Fundus photo:
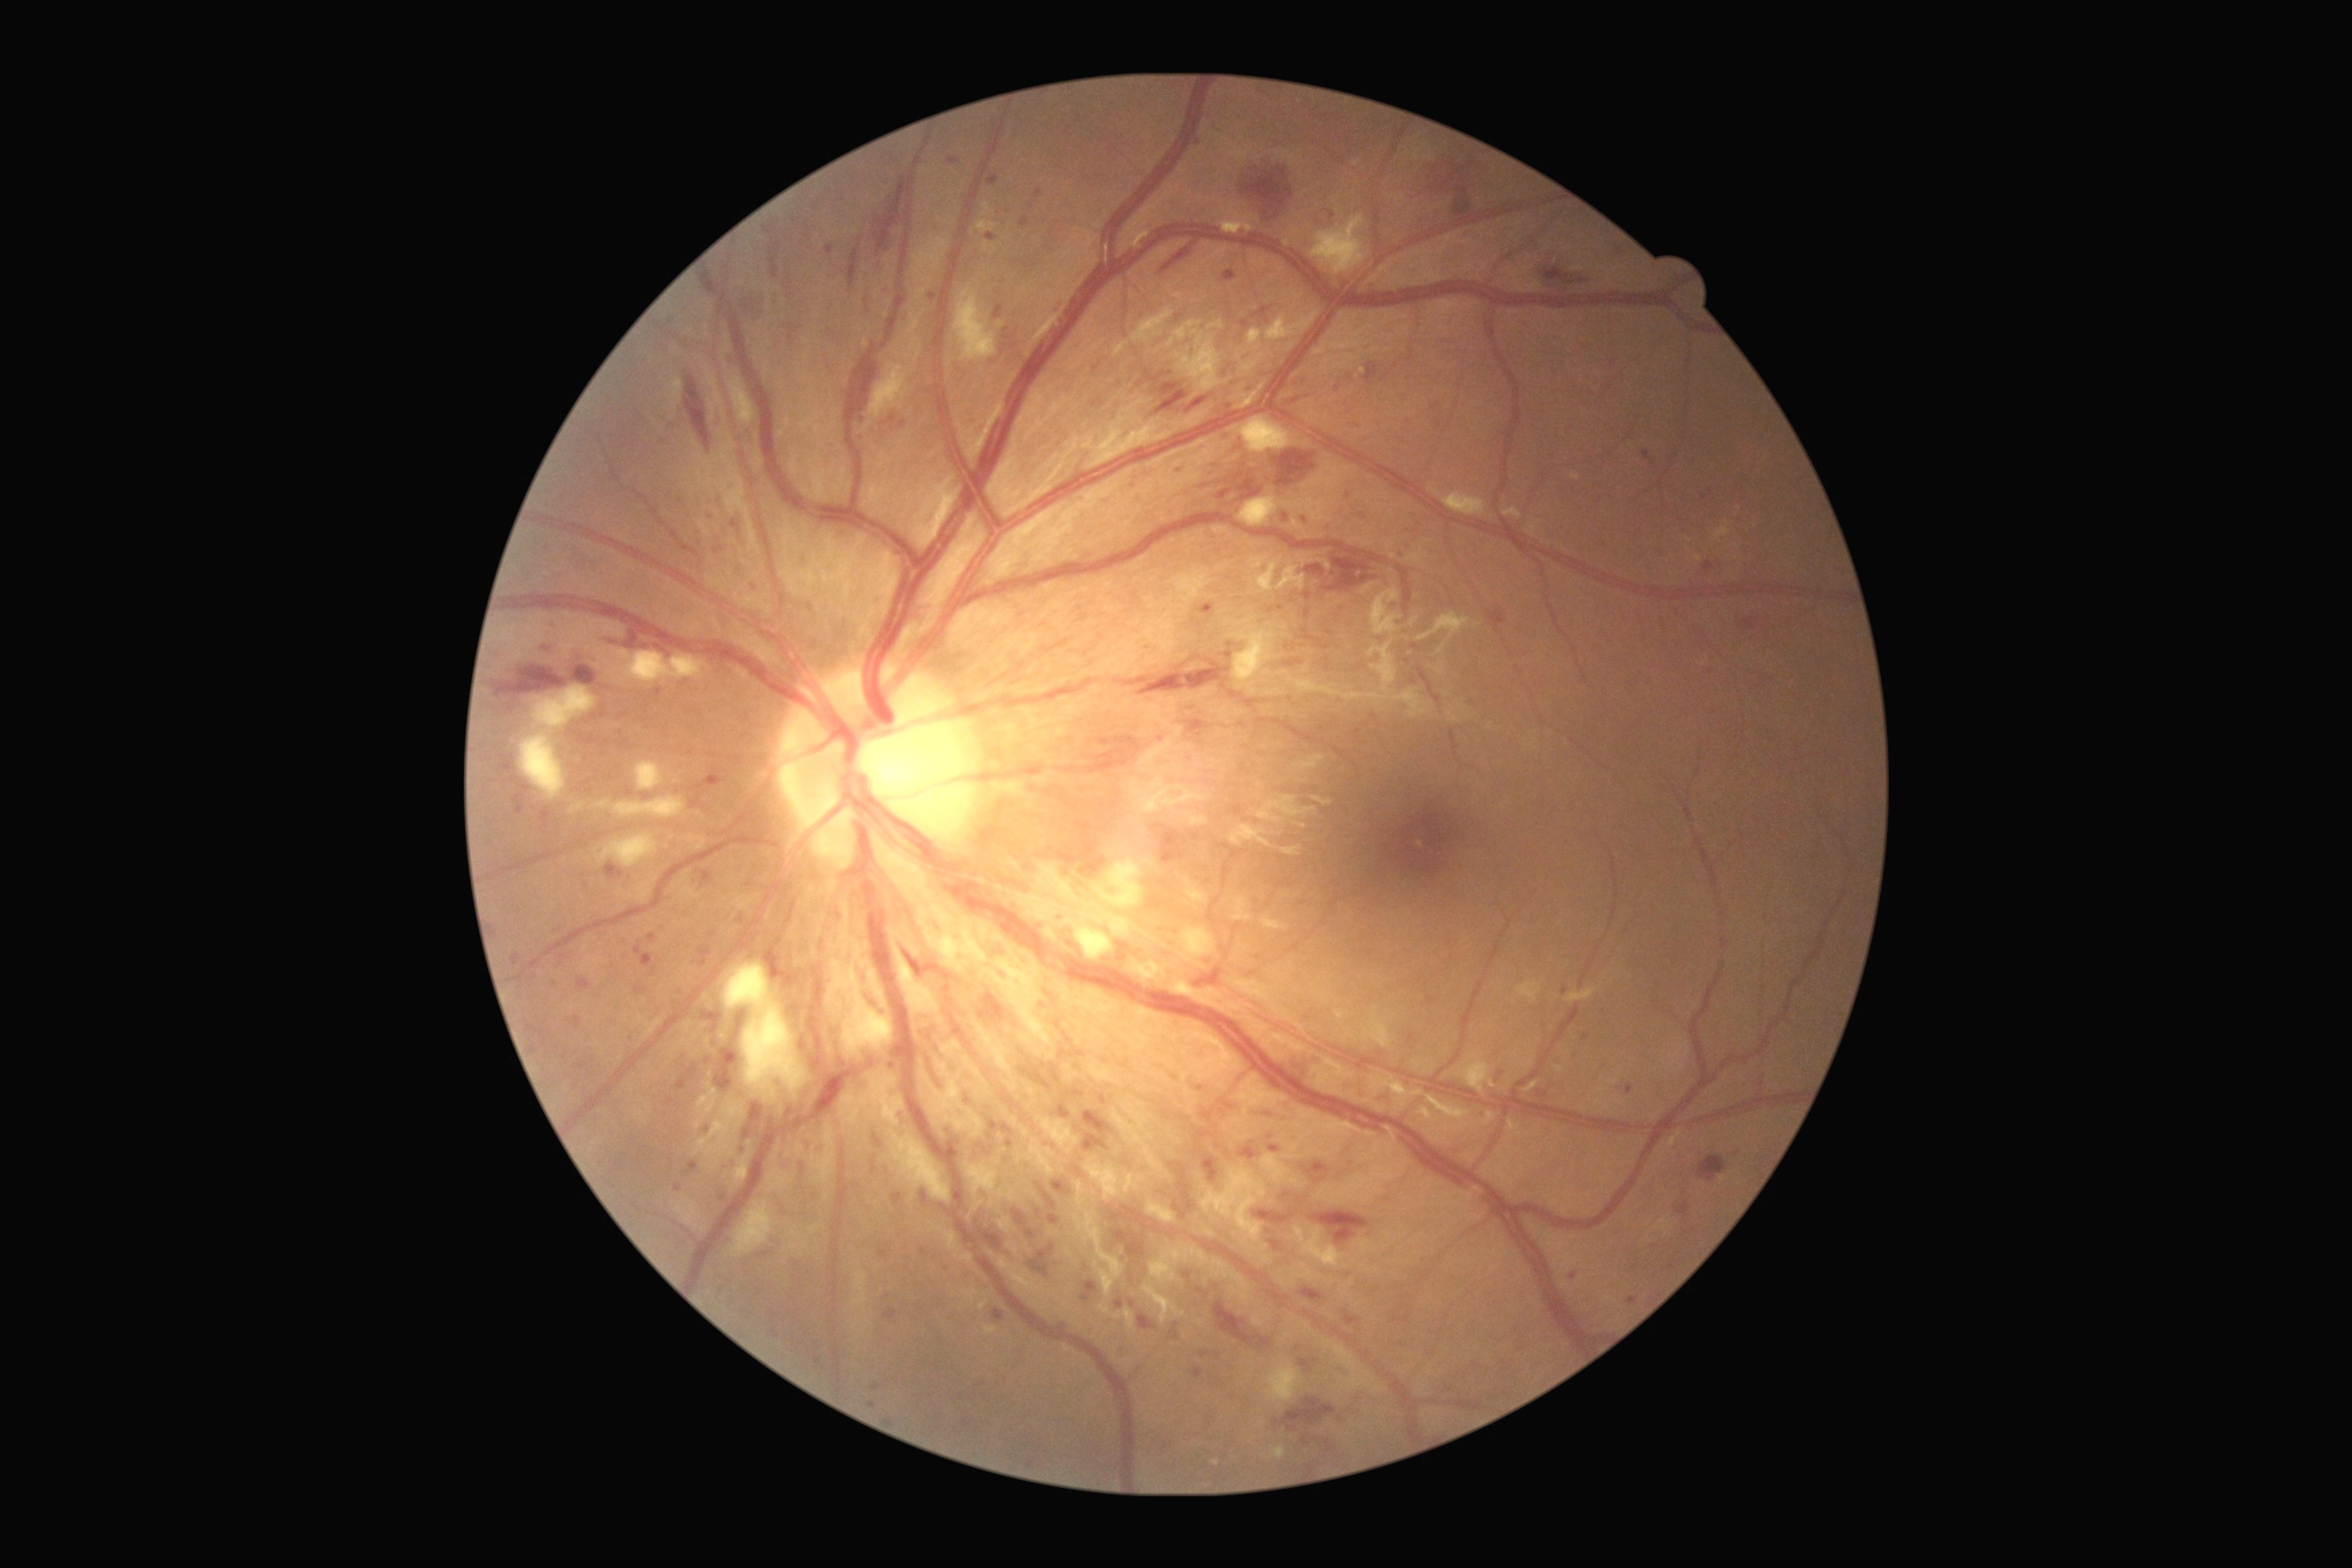

Diabetic retinopathy grade is 3
A subset of detected lesions:
hard exudates (partial) = (left=1716, top=522, right=1730, bottom=542); (left=977, top=220, right=995, bottom=233); (left=1696, top=556, right=1703, bottom=564); (left=983, top=202, right=994, bottom=217); (left=734, top=1153, right=750, bottom=1184)
Additional small hard exudates near point(1688, 540); point(1737, 547); point(1356, 163)
hemorrhages (partial) = (left=1366, top=364, right=1378, bottom=384); (left=544, top=642, right=558, bottom=654); (left=1230, top=692, right=1242, bottom=700); (left=1302, top=551, right=1378, bottom=591); (left=1210, top=447, right=1322, bottom=507); (left=876, top=172, right=908, bottom=250); (left=765, top=946, right=798, bottom=986); (left=979, top=994, right=1006, bottom=1023); (left=745, top=1102, right=763, bottom=1141); (left=1284, top=1101, right=1289, bottom=1112); (left=1542, top=255, right=1594, bottom=291); (left=1161, top=244, right=1193, bottom=275); (left=975, top=1220, right=1015, bottom=1257); (left=1244, top=700, right=1260, bottom=709); (left=1456, top=188, right=1478, bottom=217); (left=734, top=1010, right=747, bottom=1041)
soft exudates (partial) = (left=1260, top=916, right=1288, bottom=932); (left=1044, top=928, right=1055, bottom=939); (left=732, top=1202, right=774, bottom=1257); (left=1075, top=923, right=1115, bottom=961); (left=596, top=836, right=660, bottom=867); (left=1504, top=507, right=1522, bottom=520); (left=534, top=687, right=594, bottom=732); (left=667, top=380, right=683, bottom=413); (left=890, top=932, right=941, bottom=1014); (left=636, top=761, right=665, bottom=790); (left=1571, top=473, right=1580, bottom=480); (left=1311, top=215, right=1367, bottom=275); (left=1442, top=491, right=1487, bottom=518); (left=725, top=963, right=805, bottom=1099); (left=1015, top=863, right=1079, bottom=921); (left=1113, top=309, right=1175, bottom=358)
Additional small soft exudates near point(1155, 941); point(1095, 905); point(1198, 965)
microaneurysms (partial) = (left=1355, top=730, right=1360, bottom=738); (left=818, top=1146, right=827, bottom=1153); (left=1271, top=1240, right=1280, bottom=1251); (left=789, top=1004, right=803, bottom=1015); (left=1224, top=271, right=1237, bottom=282); (left=1409, top=1034, right=1415, bottom=1044); (left=1155, top=825, right=1188, bottom=863); (left=1255, top=306, right=1273, bottom=318); (left=1019, top=217, right=1030, bottom=228); (left=1308, top=1161, right=1329, bottom=1177); (left=1616, top=248, right=1625, bottom=257)
Additional small microaneurysms near point(776, 1334); point(1070, 944); point(767, 1254); point(562, 964); point(1635, 1268); point(1243, 440); point(749, 885); point(1307, 383)